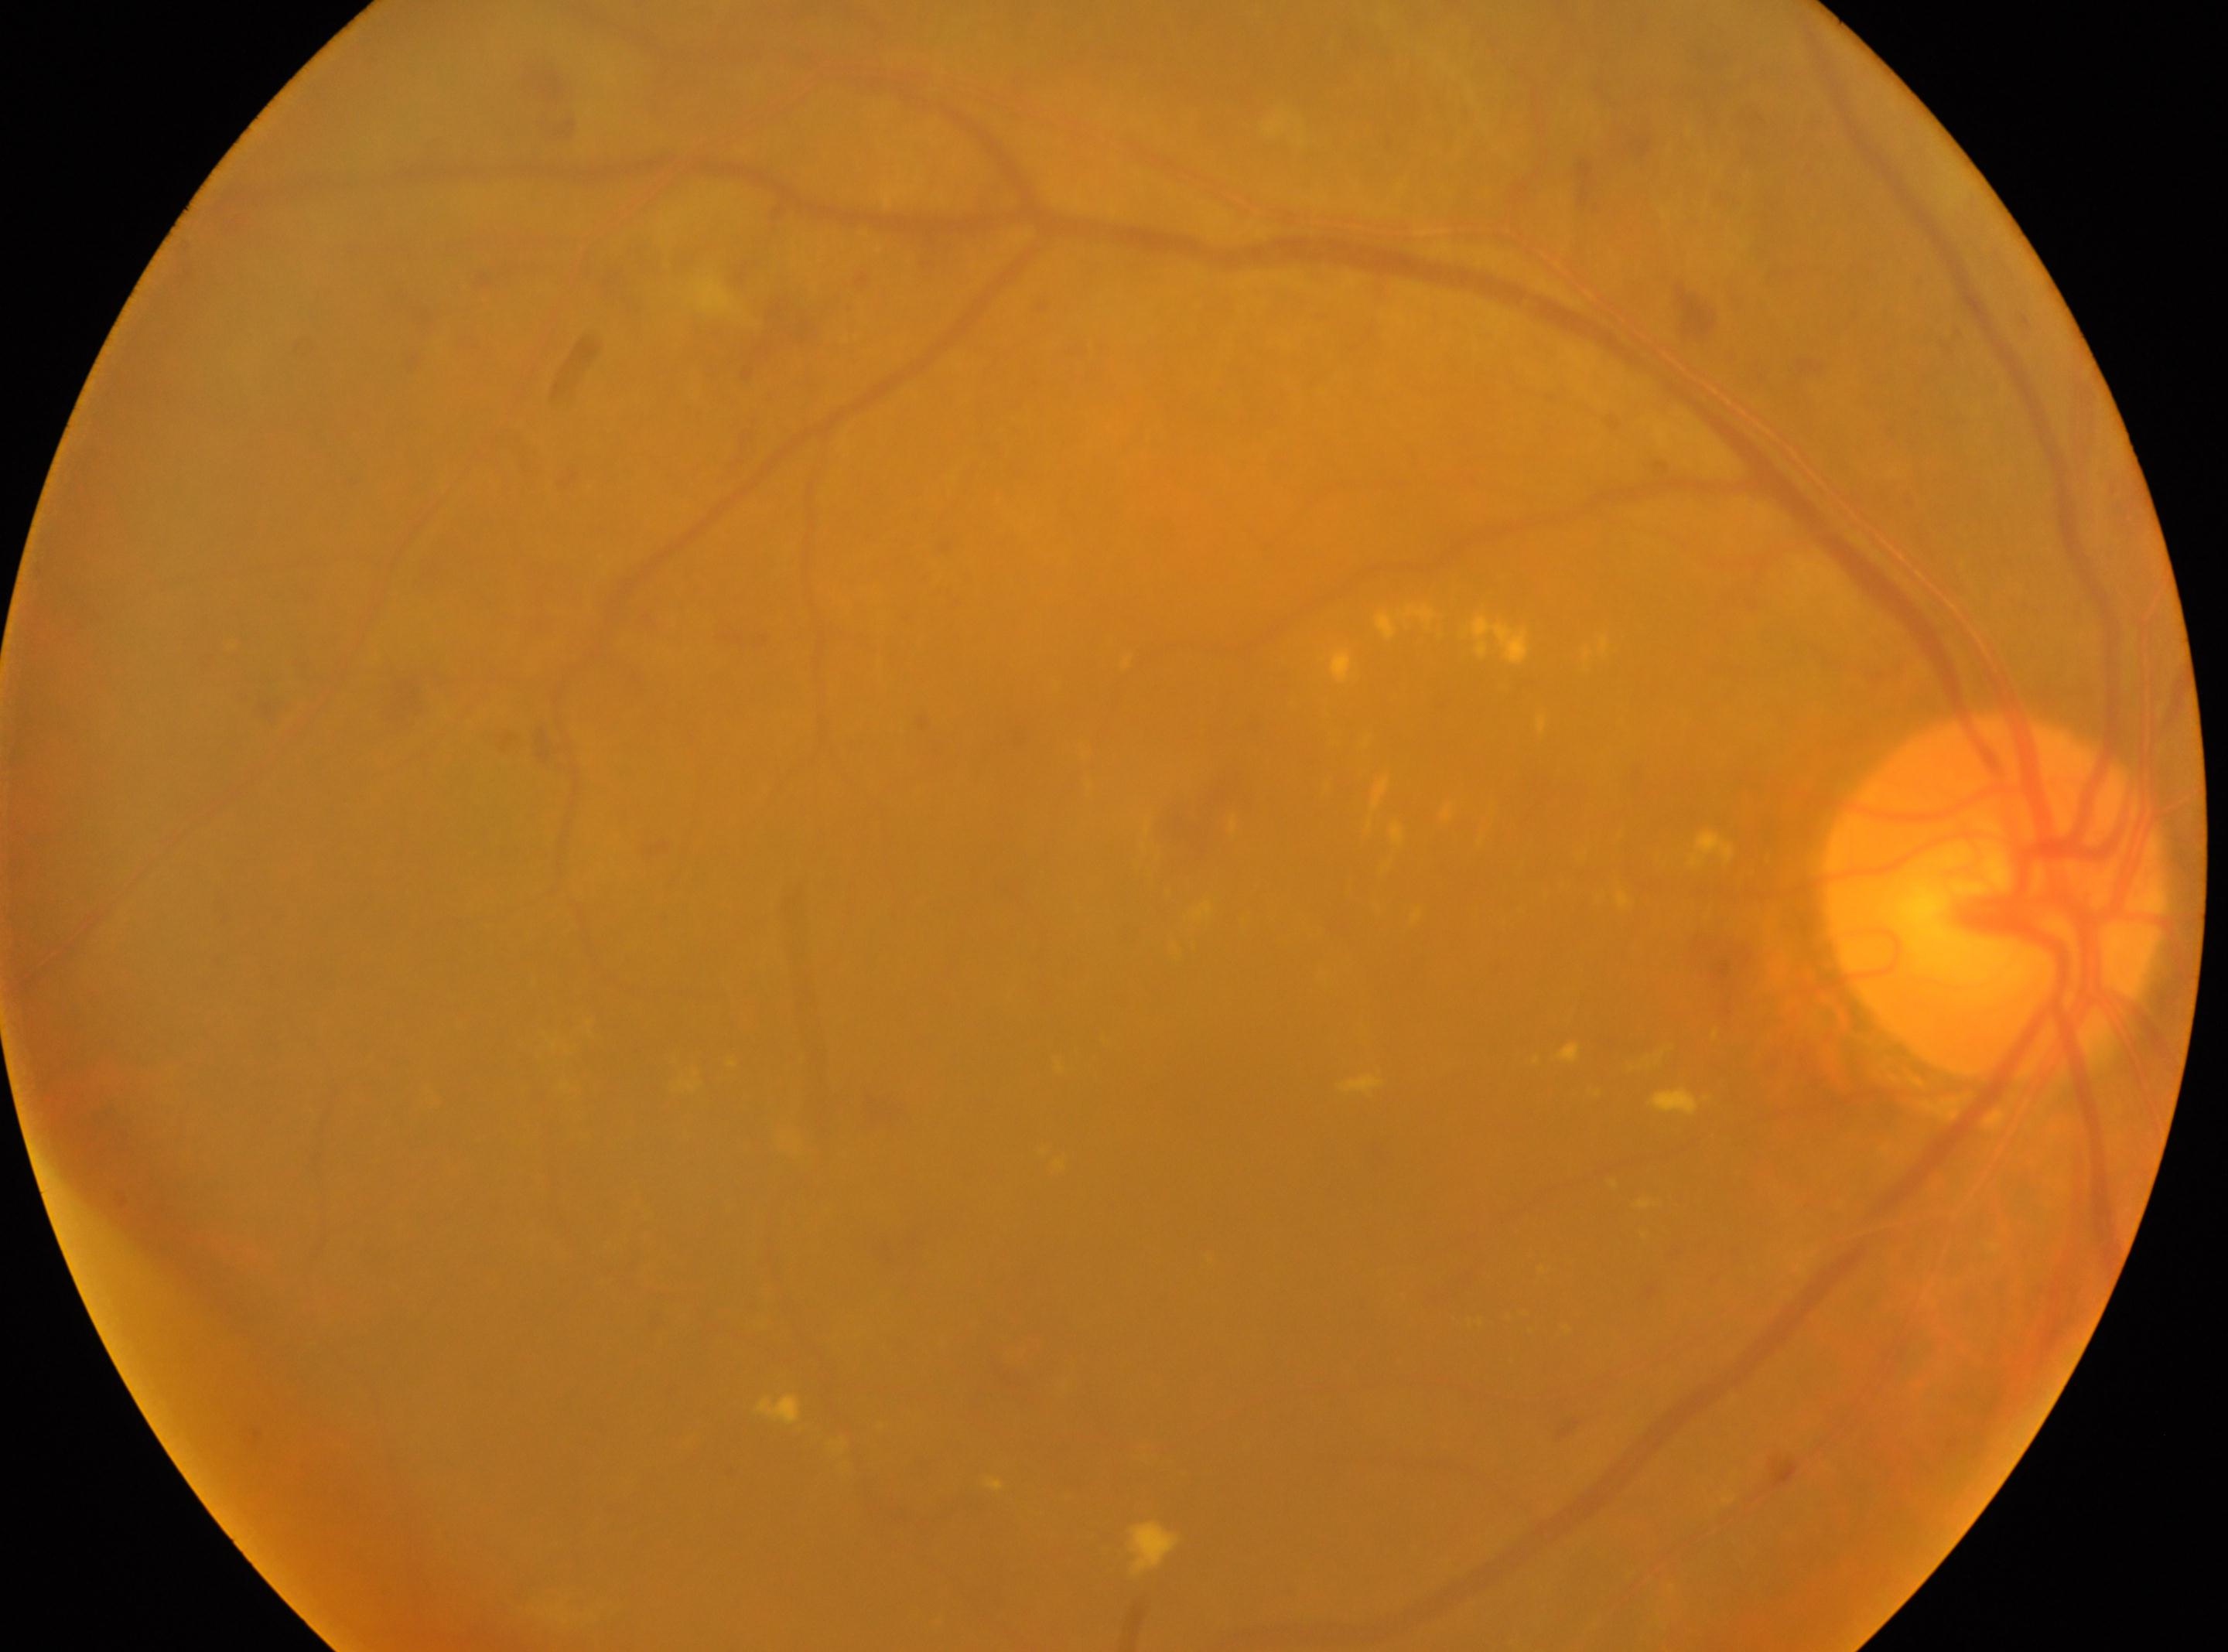
optic disk=[1993, 896]; fovea center=[1198, 1081]; right eye; diabetic retinopathy (DR)=2.